Graded on the modified Davis scale. 45 degree fundus photograph — 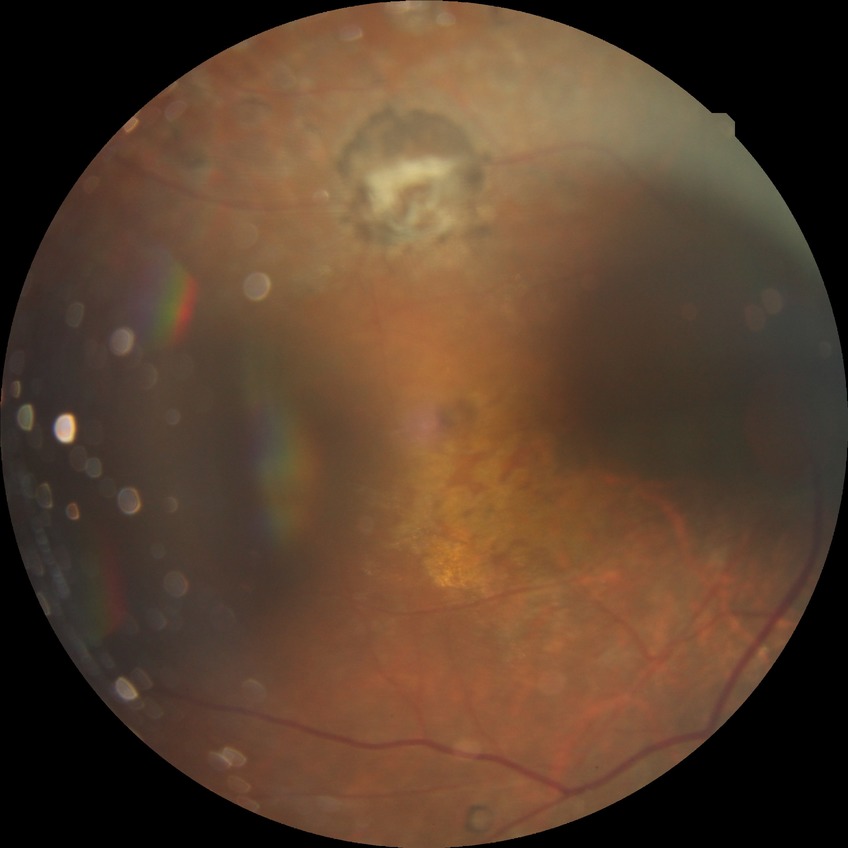
Diabetic retinopathy severity is proliferative diabetic retinopathy.